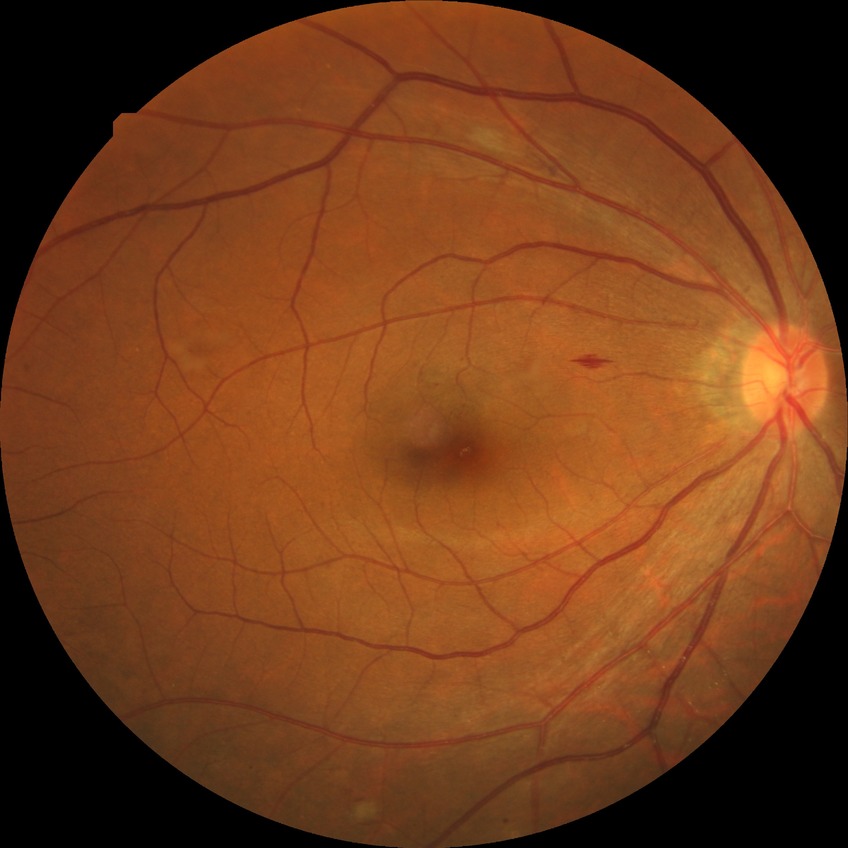
Diabetic retinopathy (DR) is PPDR (pre-proliferative diabetic retinopathy).